Wide-field fundus photograph of an infant
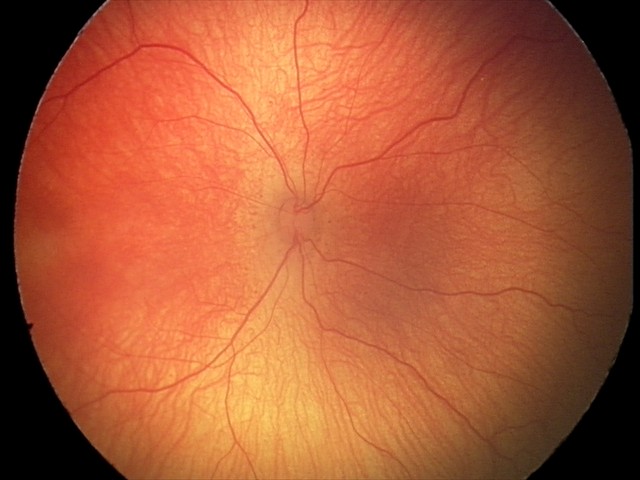

Retinopathy of prematurity stage: 2 — ridge with height and width at the demarcation line; plus form: absent.